Acquired with a Remidio FOP fundus camera: 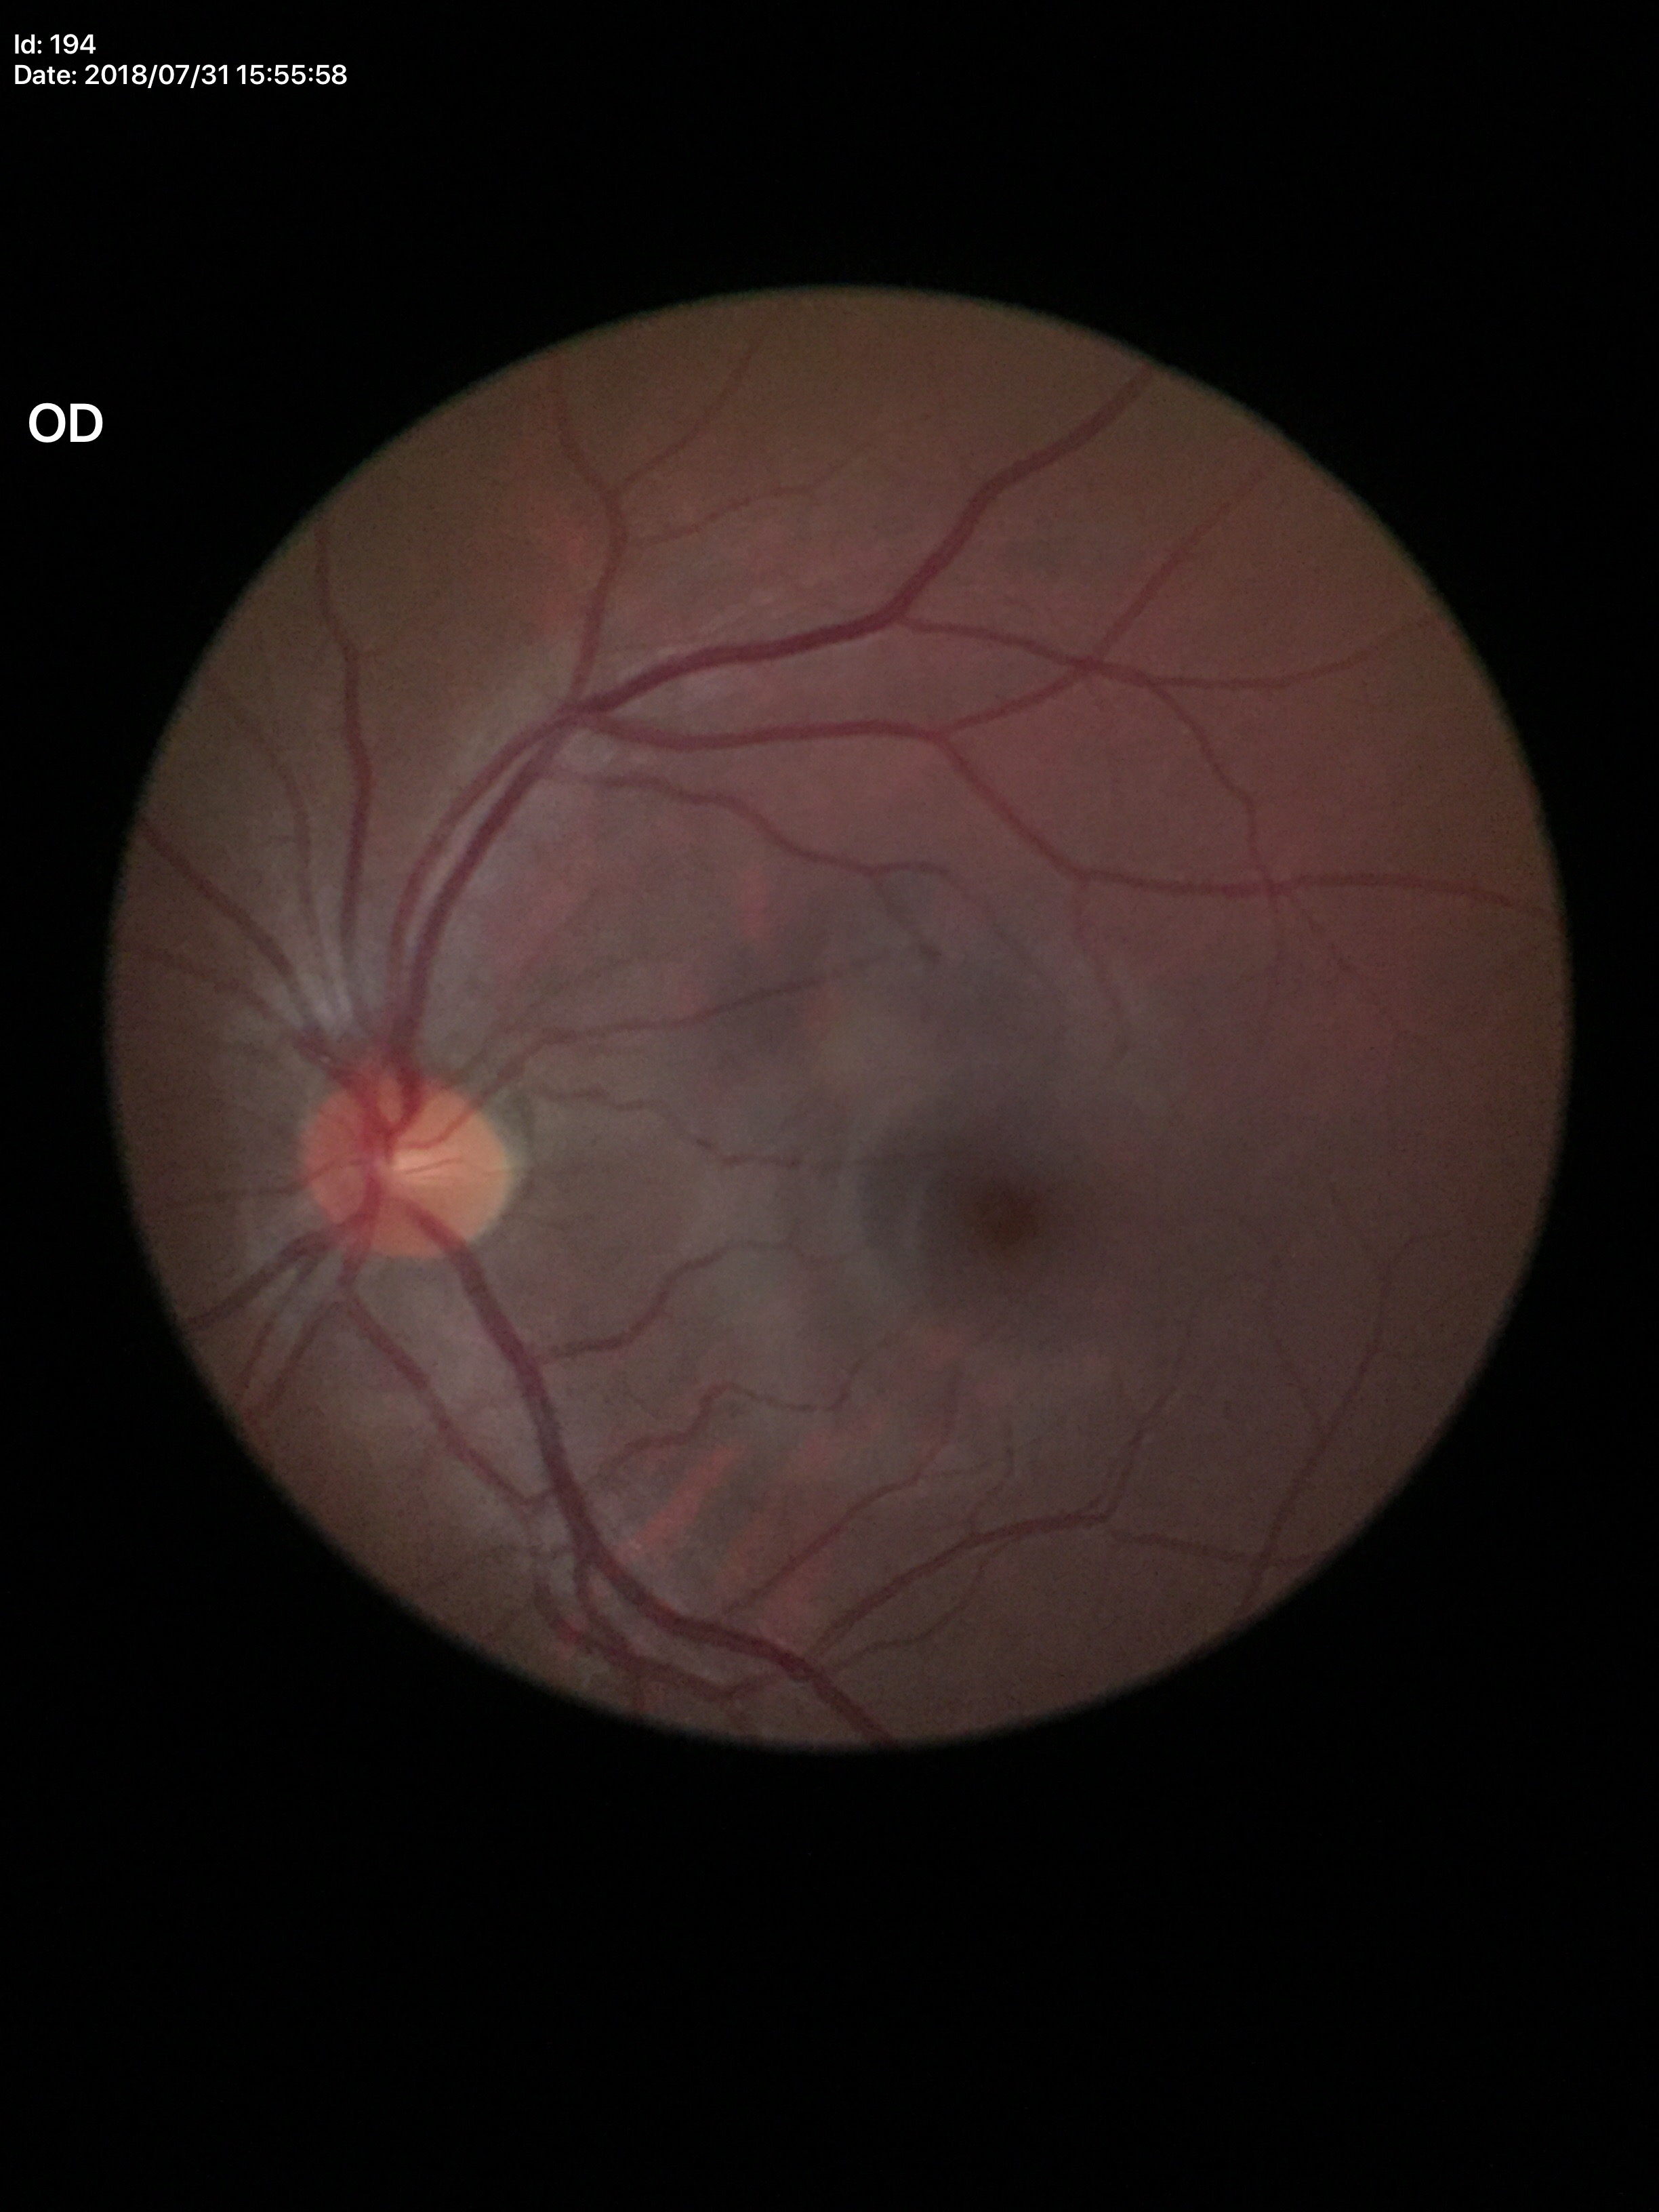

No evidence of glaucoma. Vertical CDR (VCDR) is 0.44. Horizontal cup-disc ratio (HCDR) is 0.46.